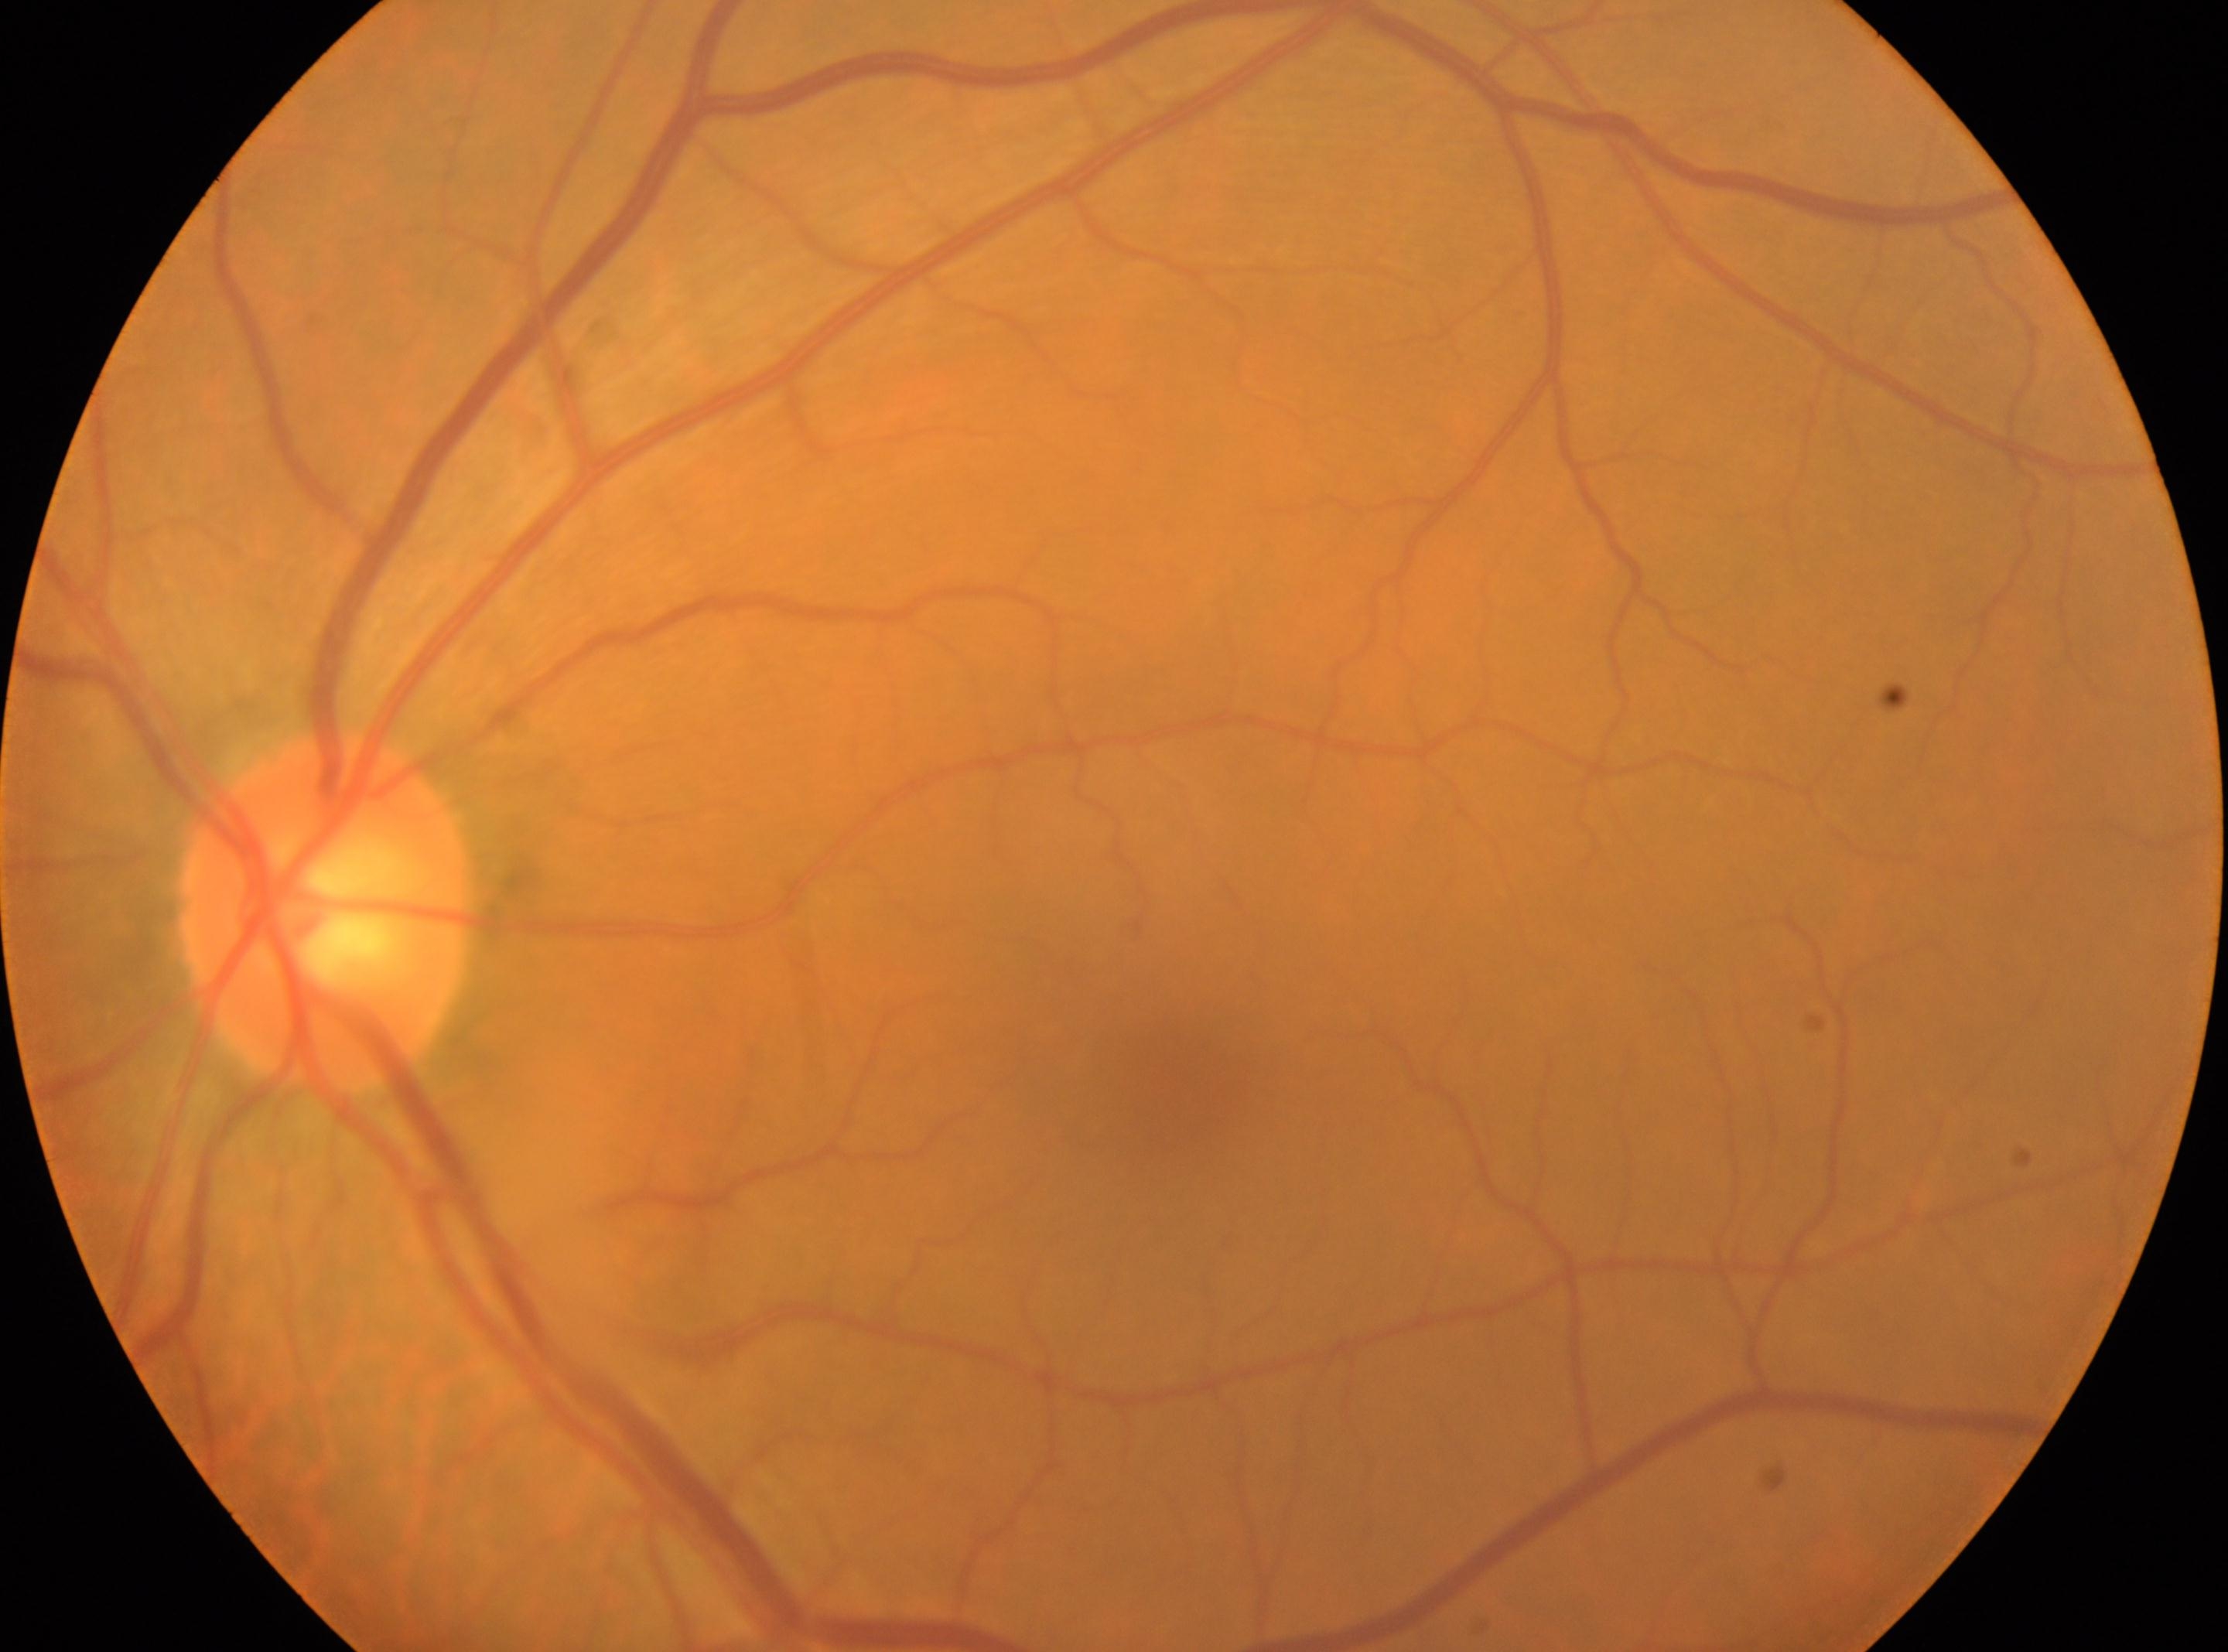
The fovea is at (1165,1084).
The image shows the left eye.
Optic nerve head: (330,914).
DR: 0.